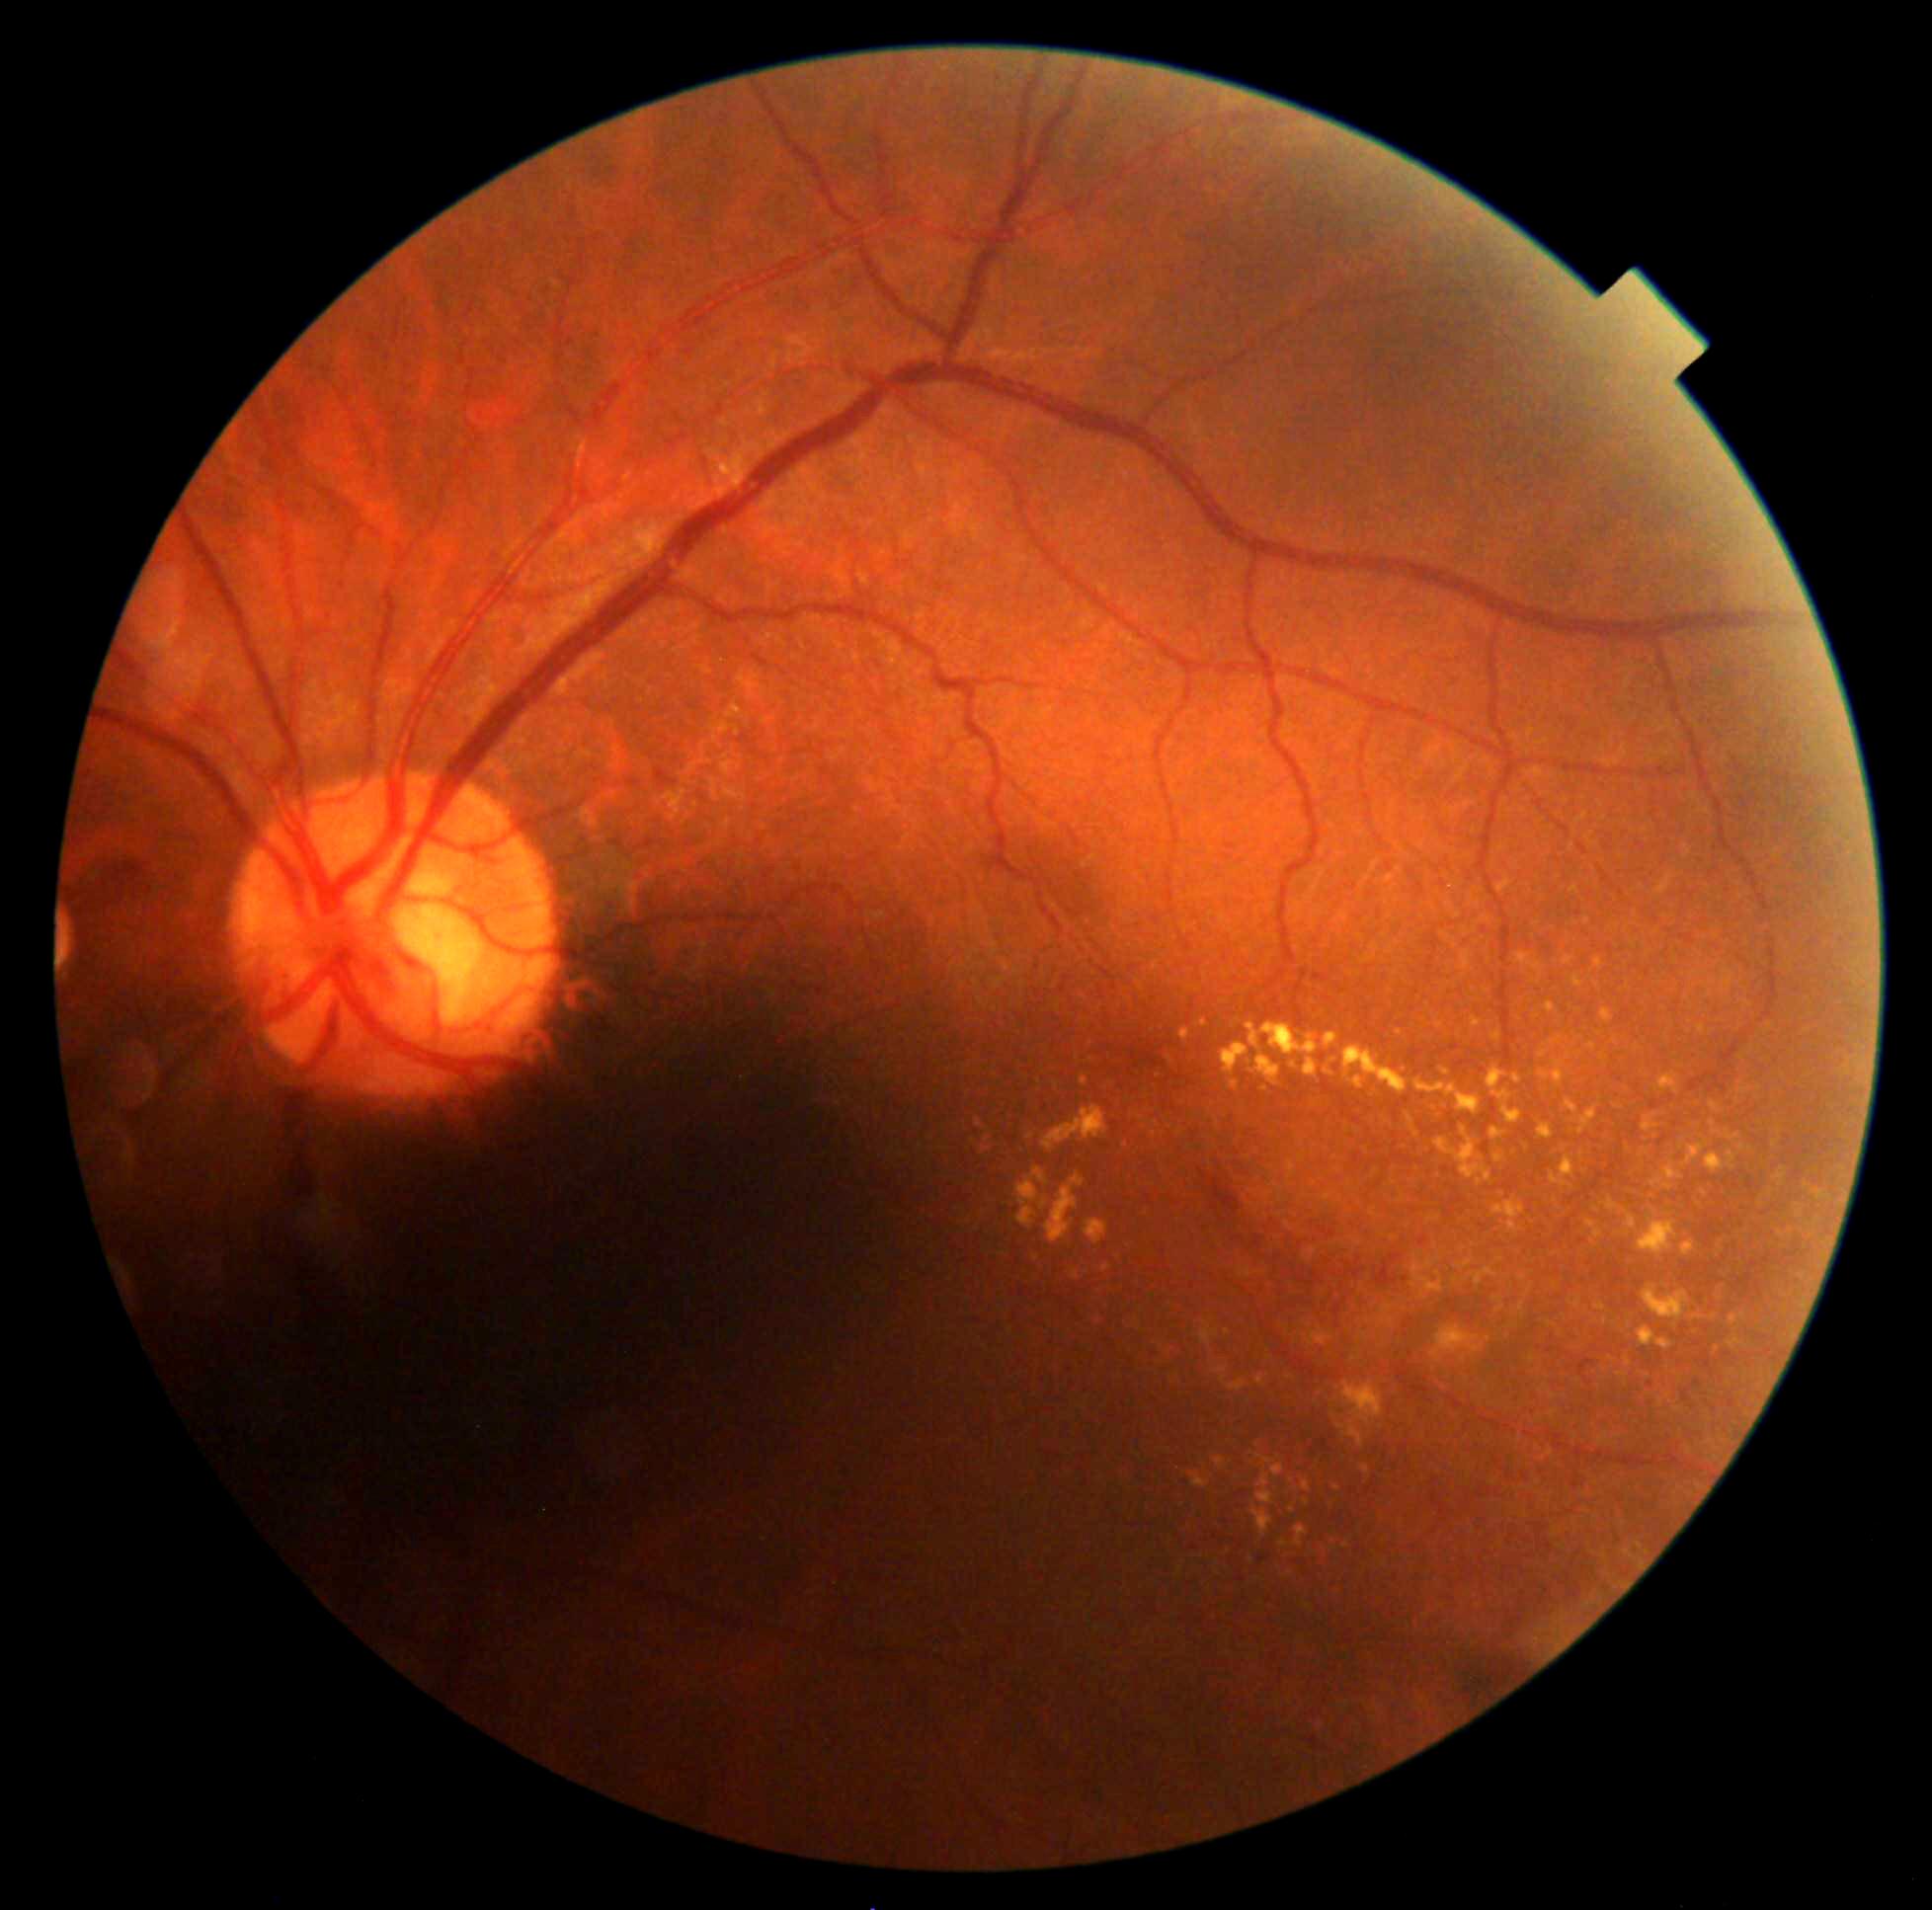

Diabetic retinopathy (DR) is moderate non-proliferative diabetic retinopathy (grade 2)
Selected lesions:
hard exudates (EXs) (continued) = bbox=(976, 1119, 983, 1128); bbox=(1493, 1200, 1526, 1234); bbox=(1199, 1321, 1219, 1349); bbox=(1804, 1302, 1809, 1312); bbox=(1513, 1074, 1522, 1085); bbox=(1045, 1174, 1085, 1243); bbox=(1773, 1167, 1788, 1187); bbox=(1491, 1031, 1502, 1042); bbox=(1517, 953, 1544, 978); bbox=(1615, 1105, 1623, 1110); bbox=(1489, 1128, 1507, 1141); bbox=(1729, 1338, 1742, 1350); bbox=(1082, 1076, 1088, 1087)
Small EXs near <pt>1140,1119</pt>; <pt>1159,1076</pt>; <pt>1290,1574</pt>; <pt>1682,1146</pt>; <pt>1158,1124</pt>; <pt>1217,1126</pt>